Without pupil dilation, 848x848: 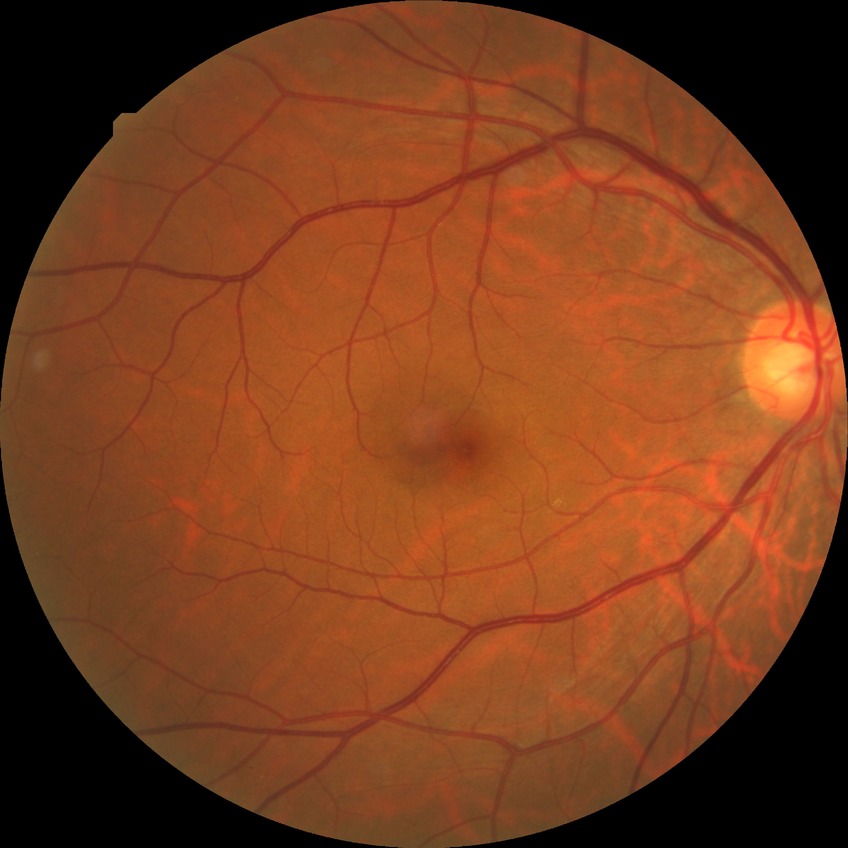 diabetic retinopathy stage = no diabetic retinopathy